45° field of view; 2048 x 1536 pixels — 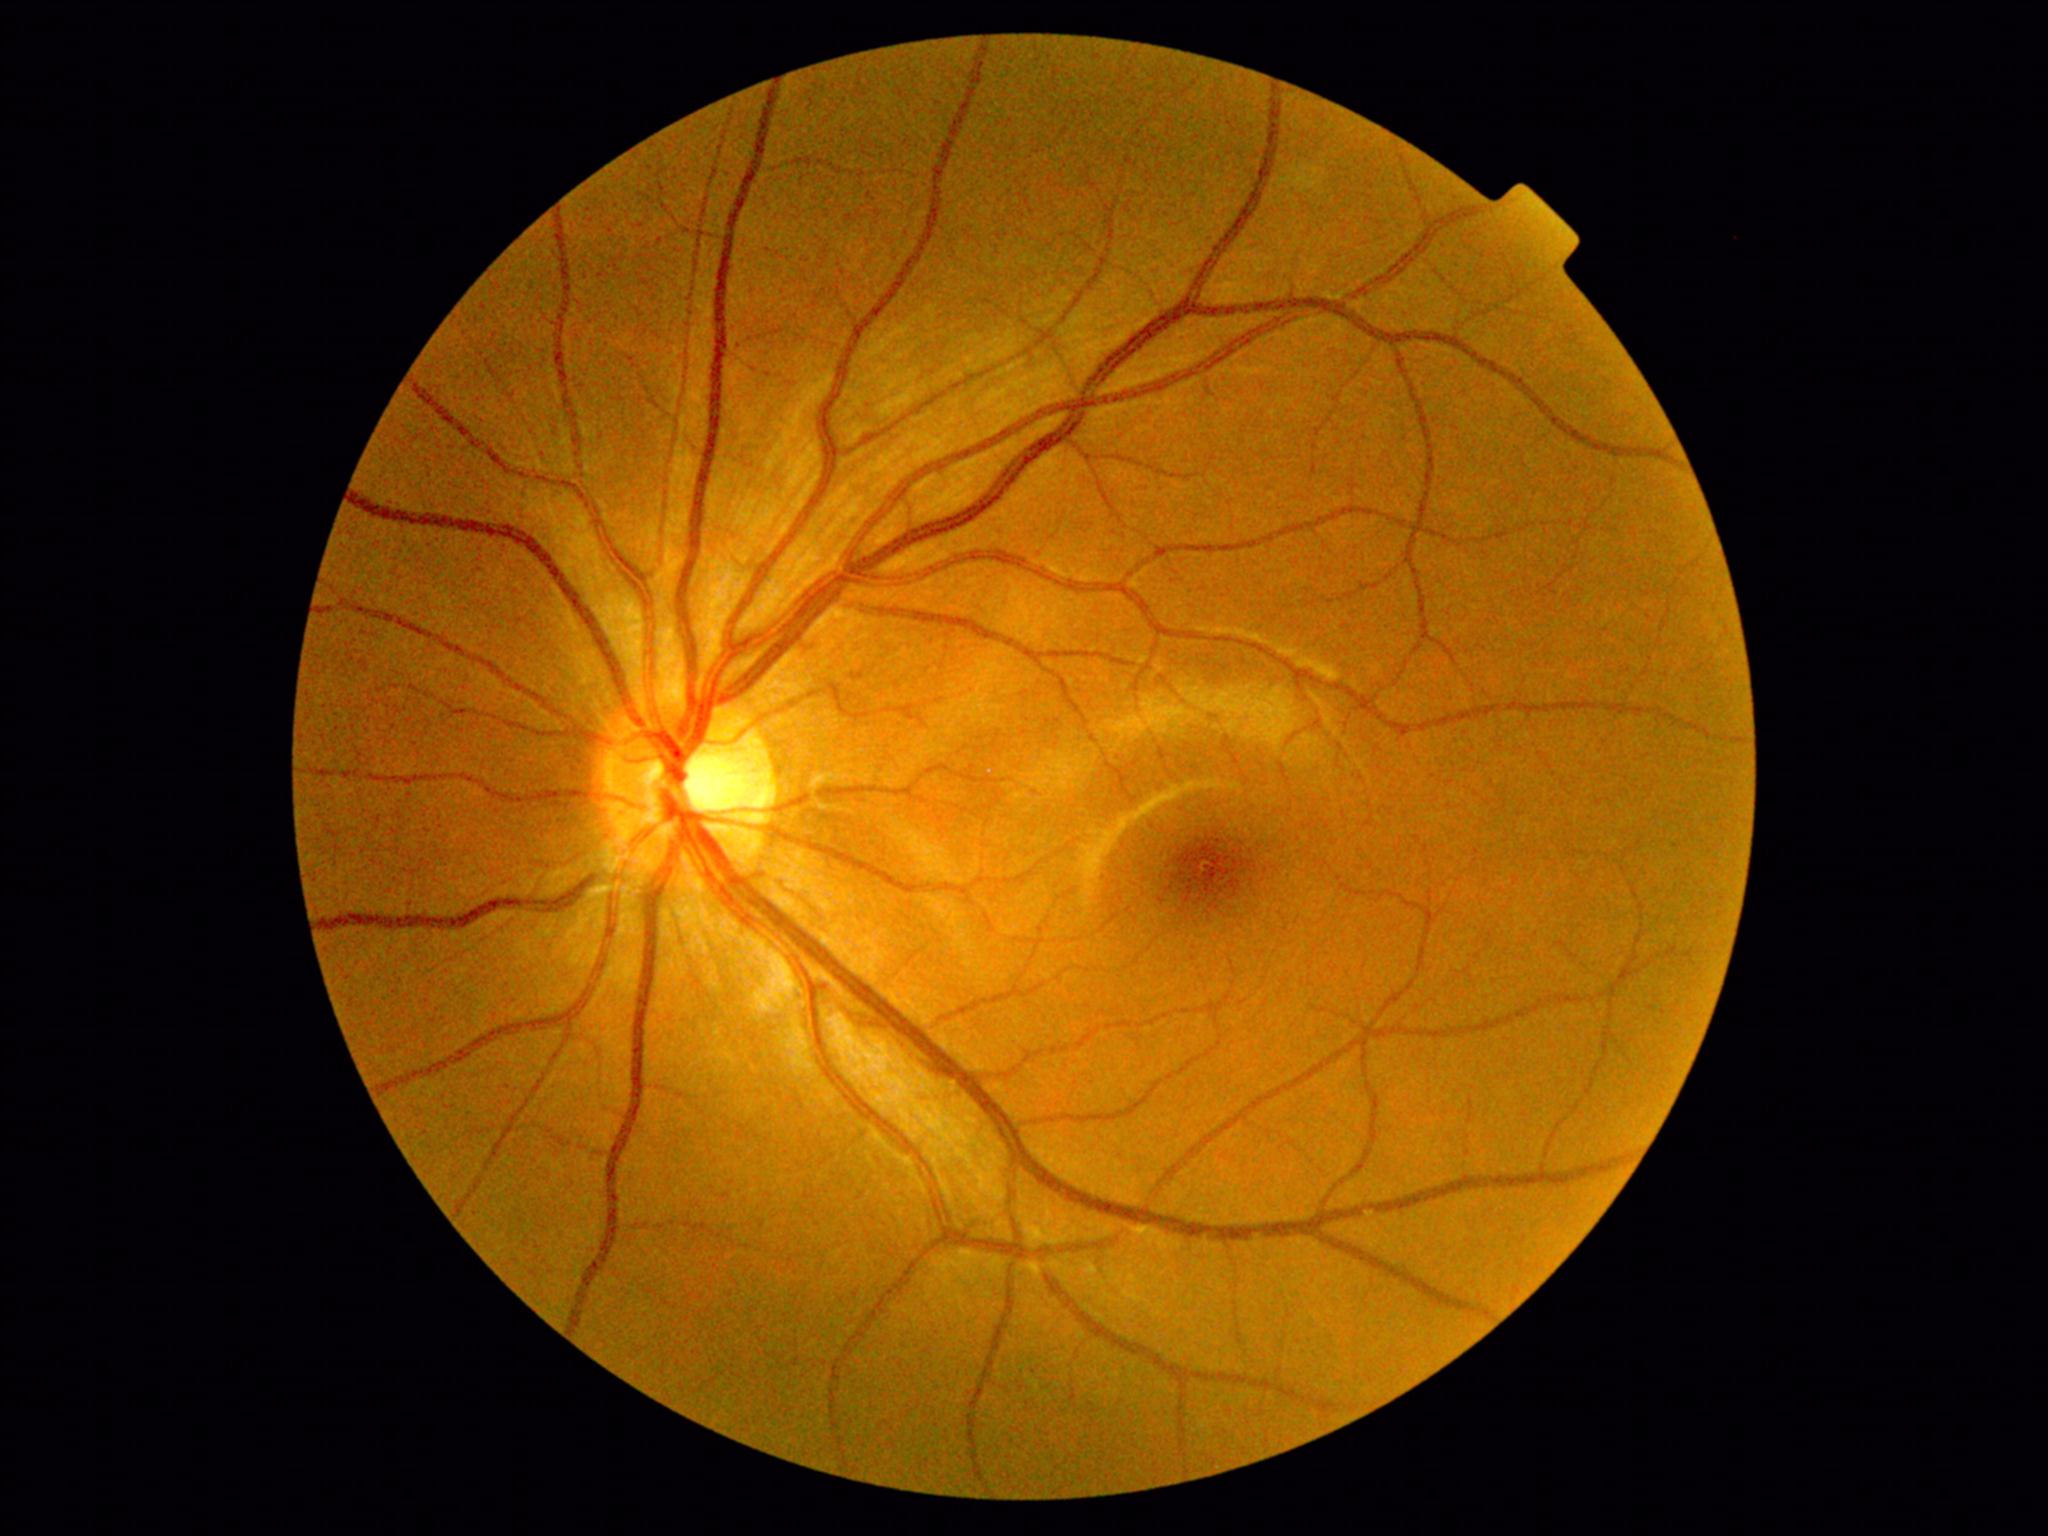

Diabetic retinopathy: grade 0.